45° FOV — 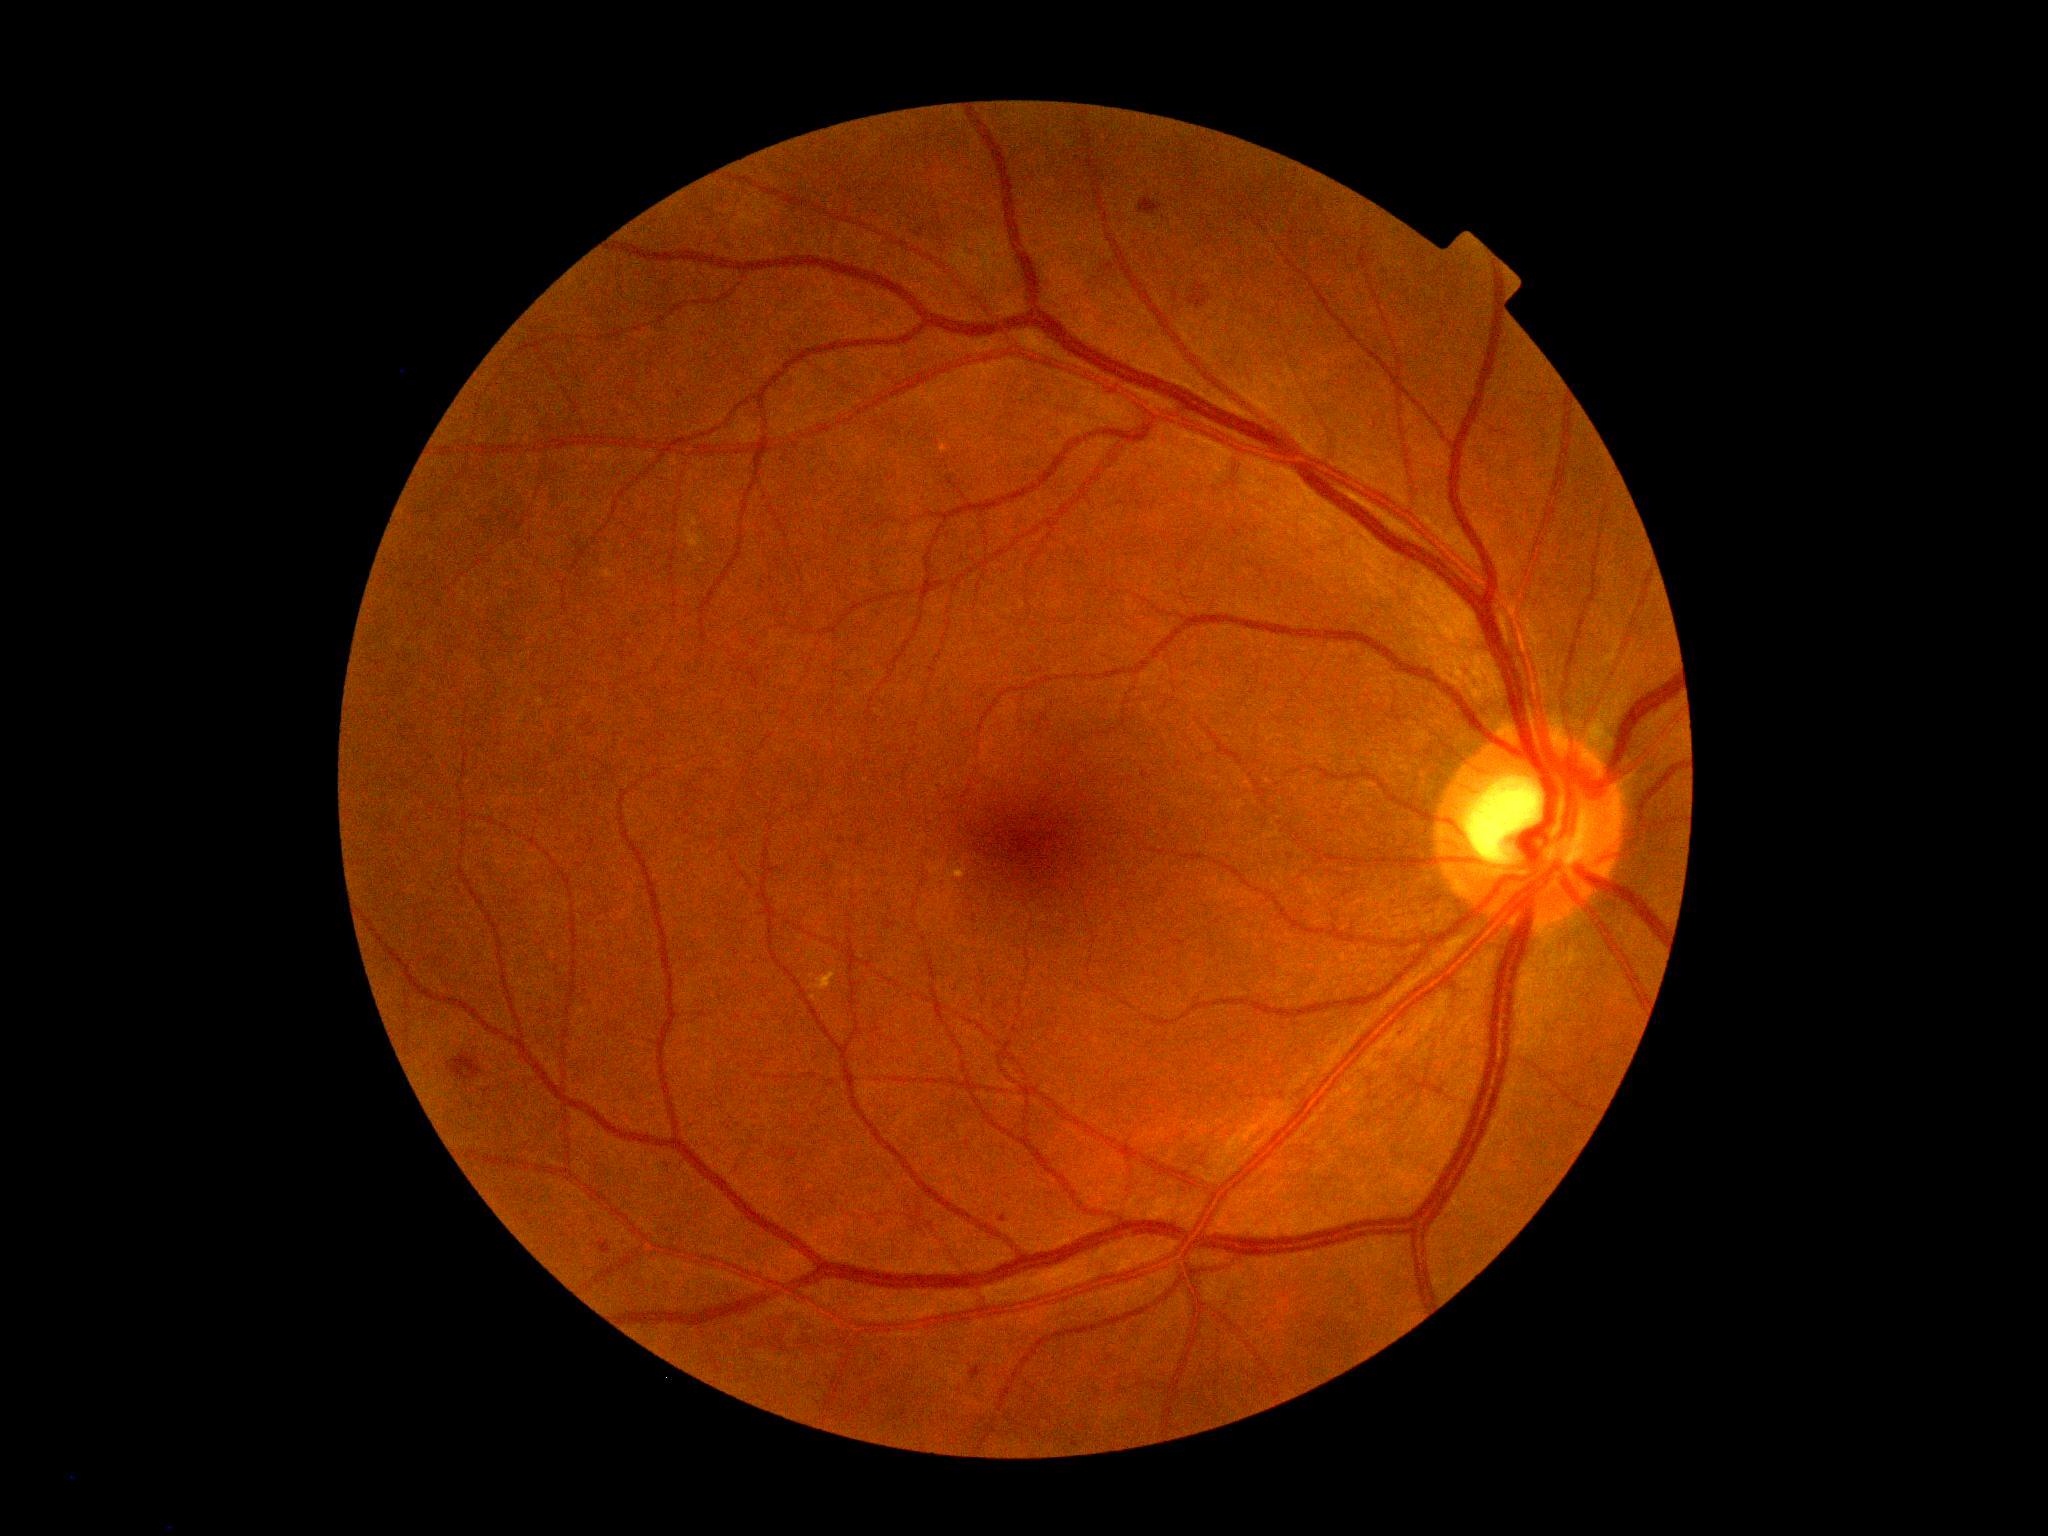 DR is grade 2 (moderate NPDR) — more than just microaneurysms but less than severe NPDR.